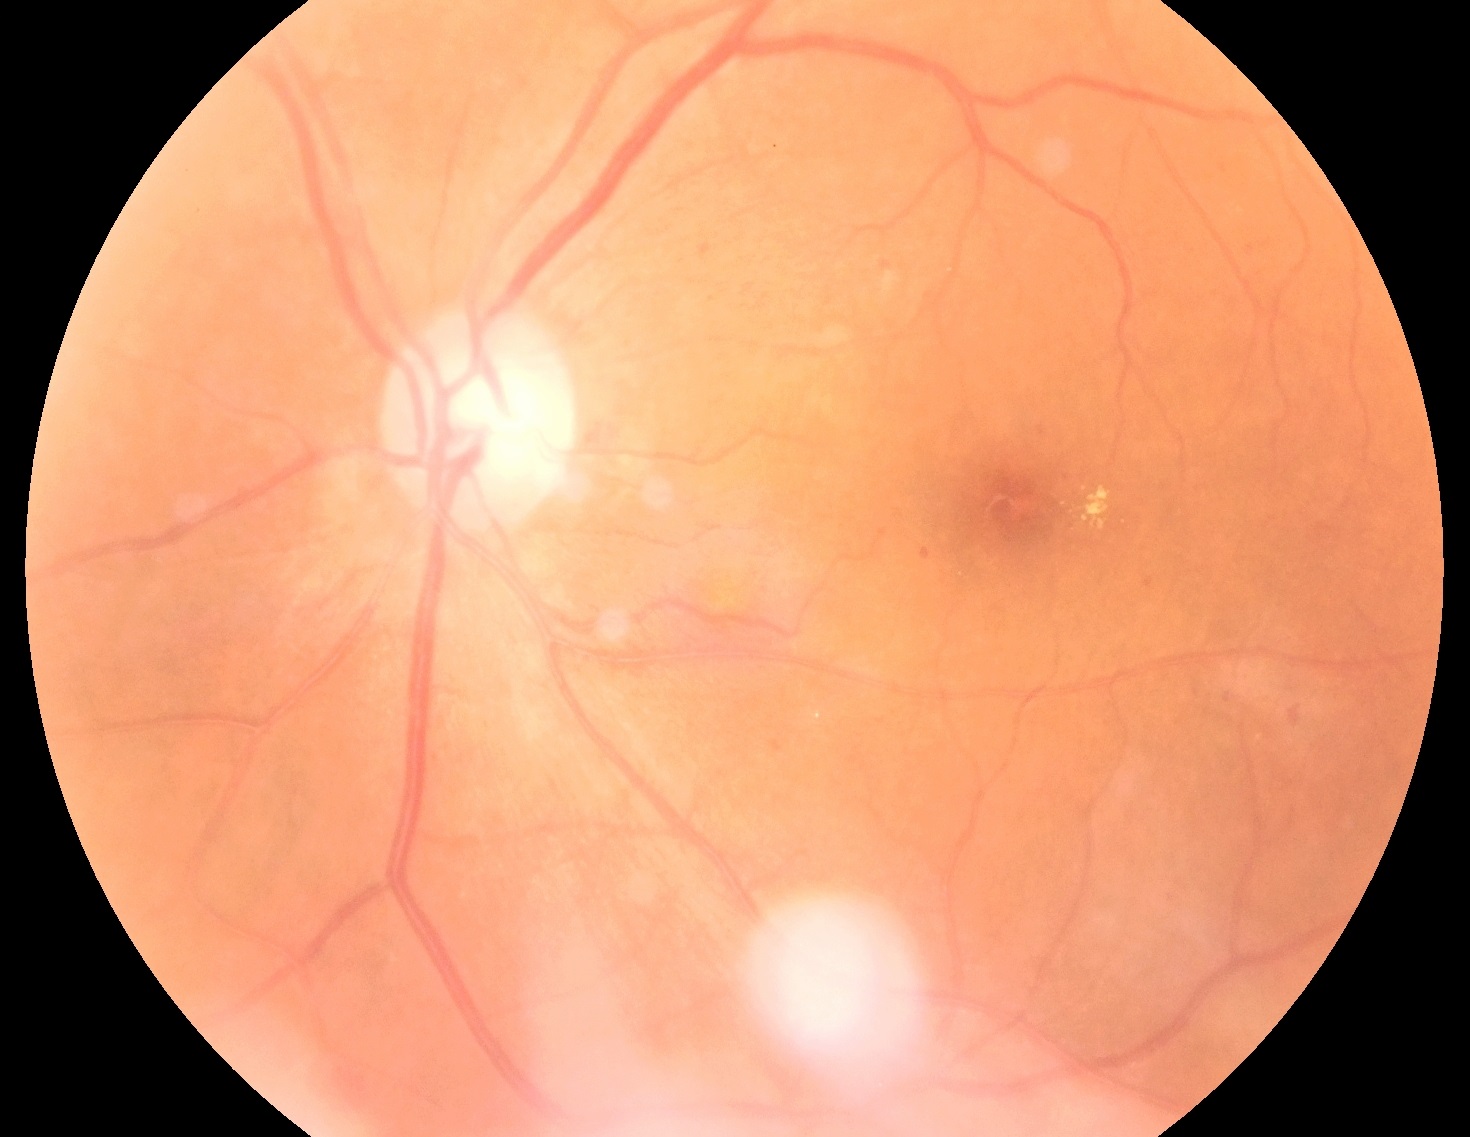 Findings:
* diabetic retinopathy: moderate NPDR (grade 2)